Wide-field contact fundus photograph of an infant: 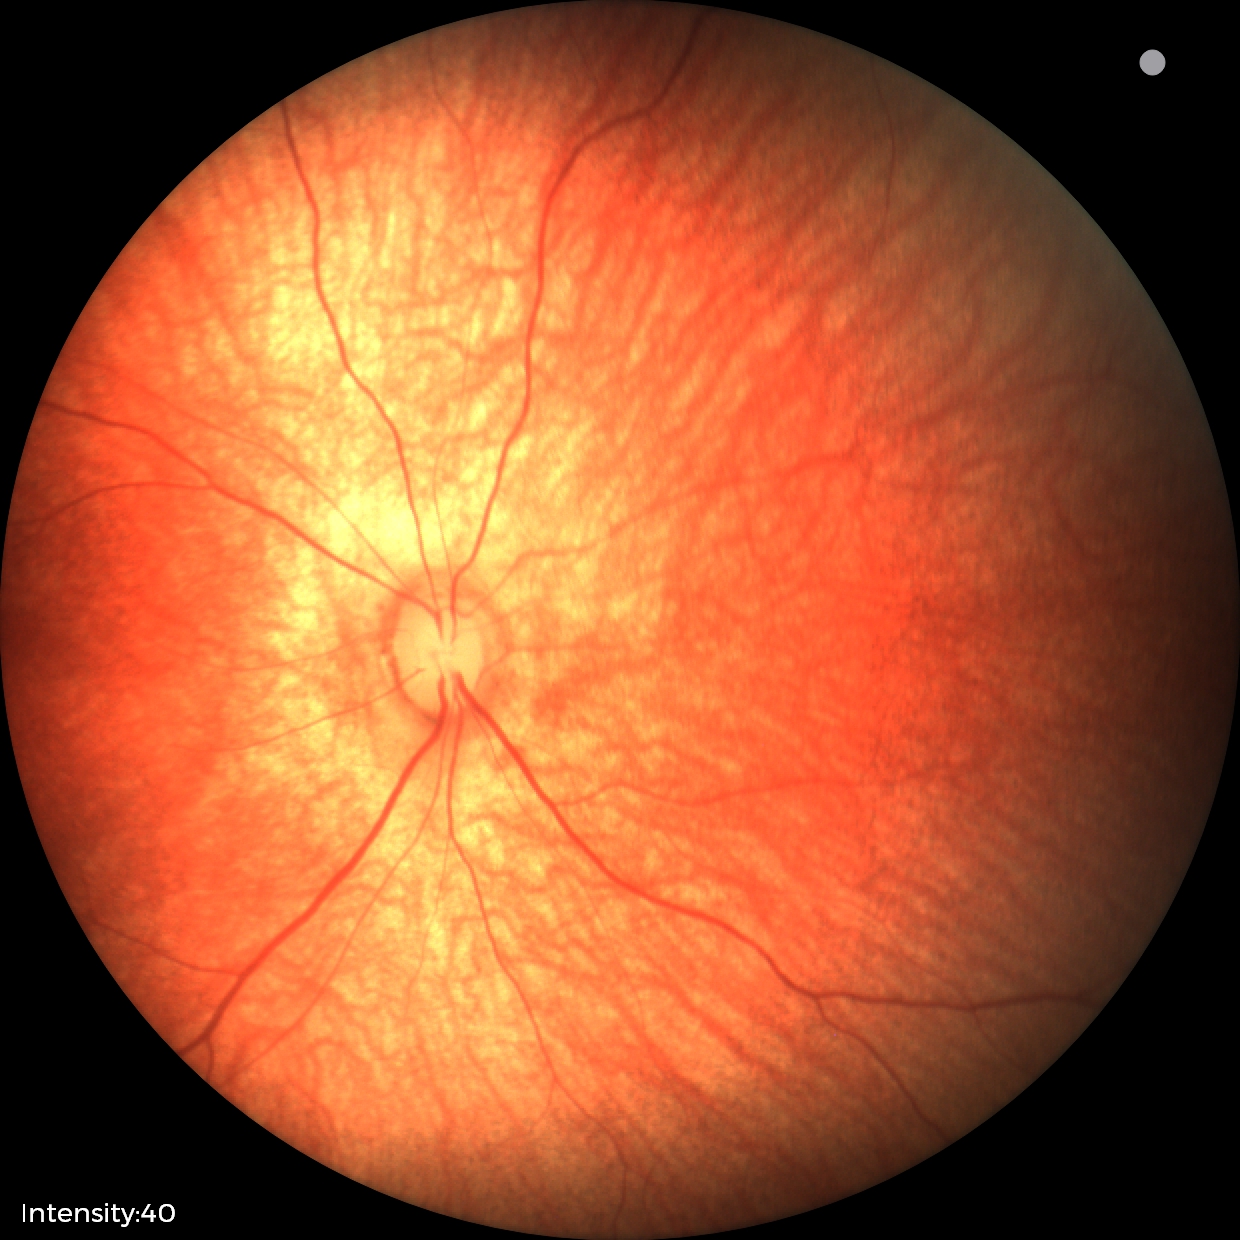 Screening diagnosis = normal retinal appearance.